Cropped from a 35-degree field of view. Optic disc photograph. Topcon TRC fundus camera
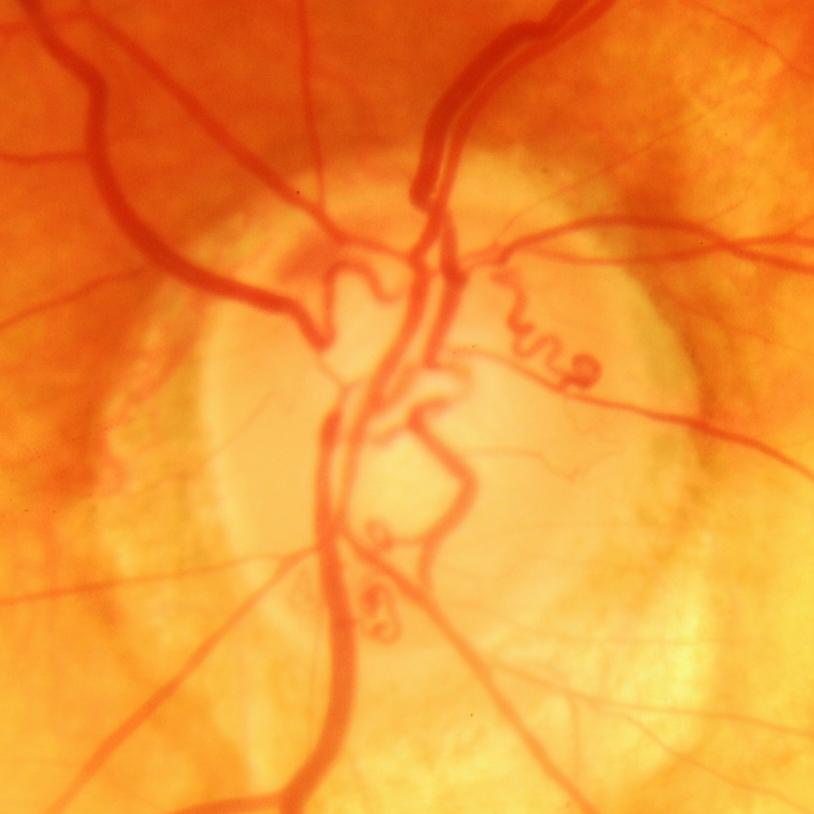

Q: Does this eye have glaucoma?
A: Glaucomatous changes.